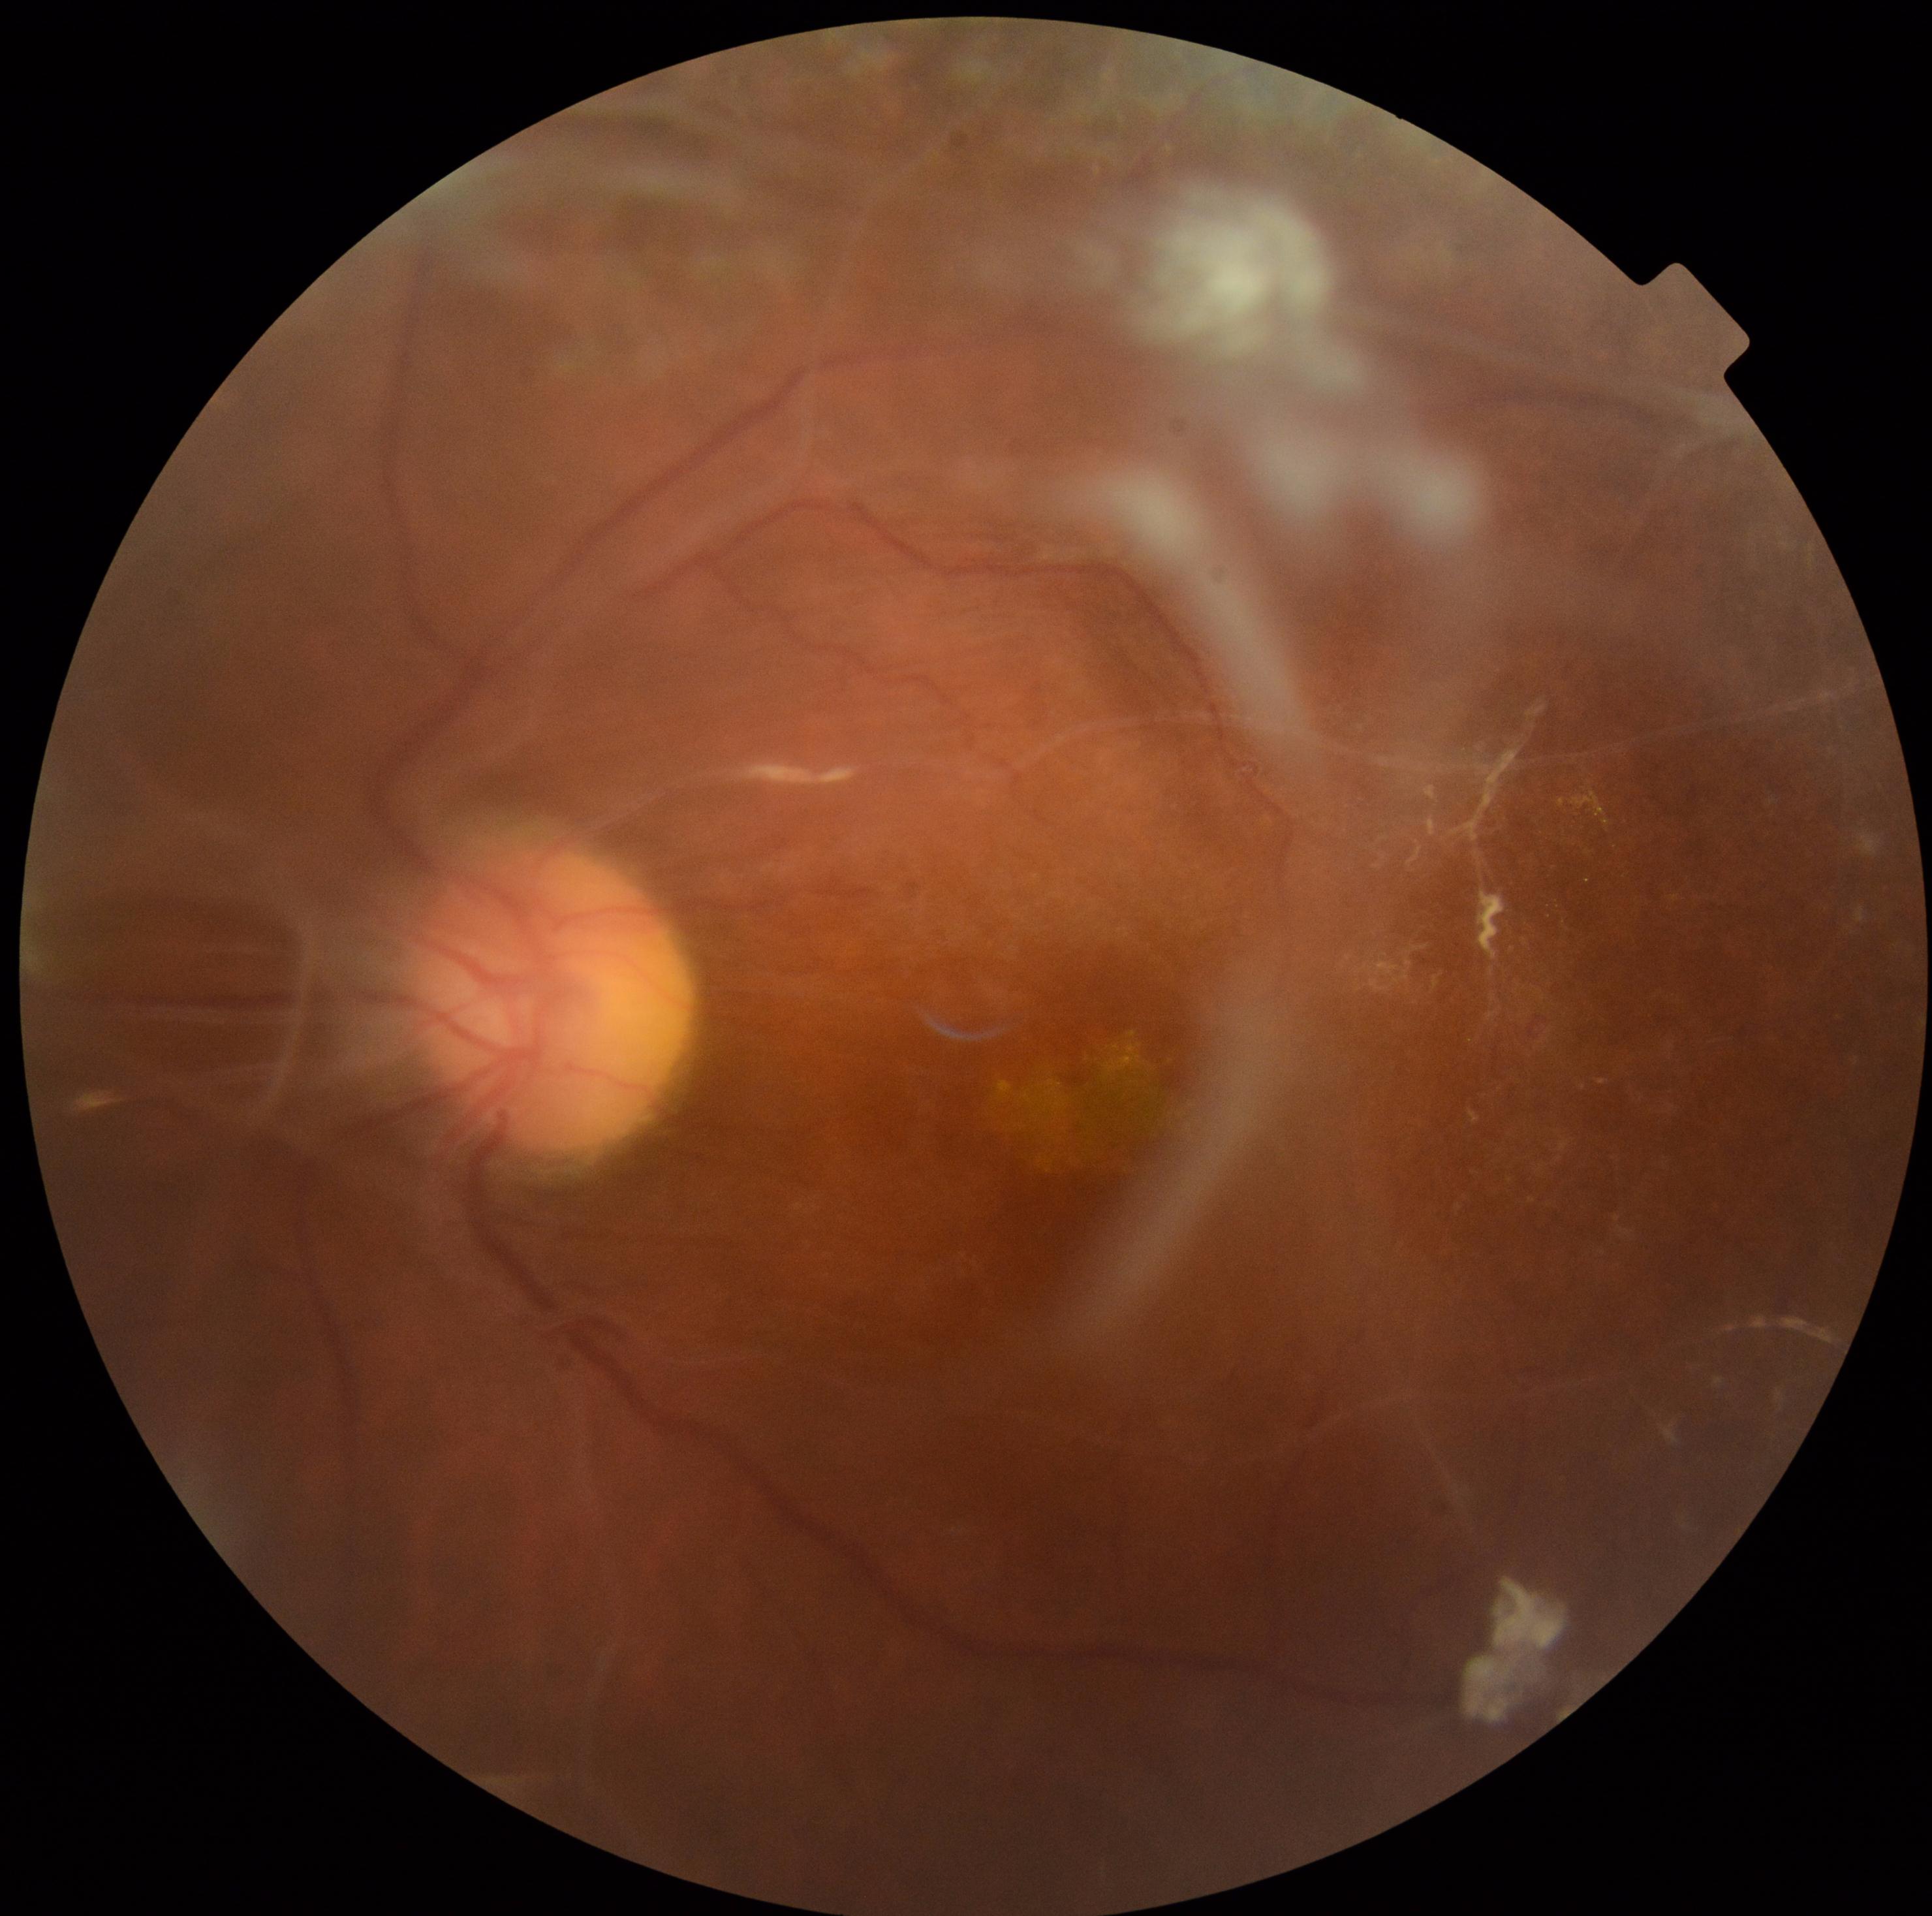

{
  "dr_grade": "4",
  "dr_category": "proliferative diabetic retinopathy"
}